Retinal fundus photograph, image size 2346x1568: 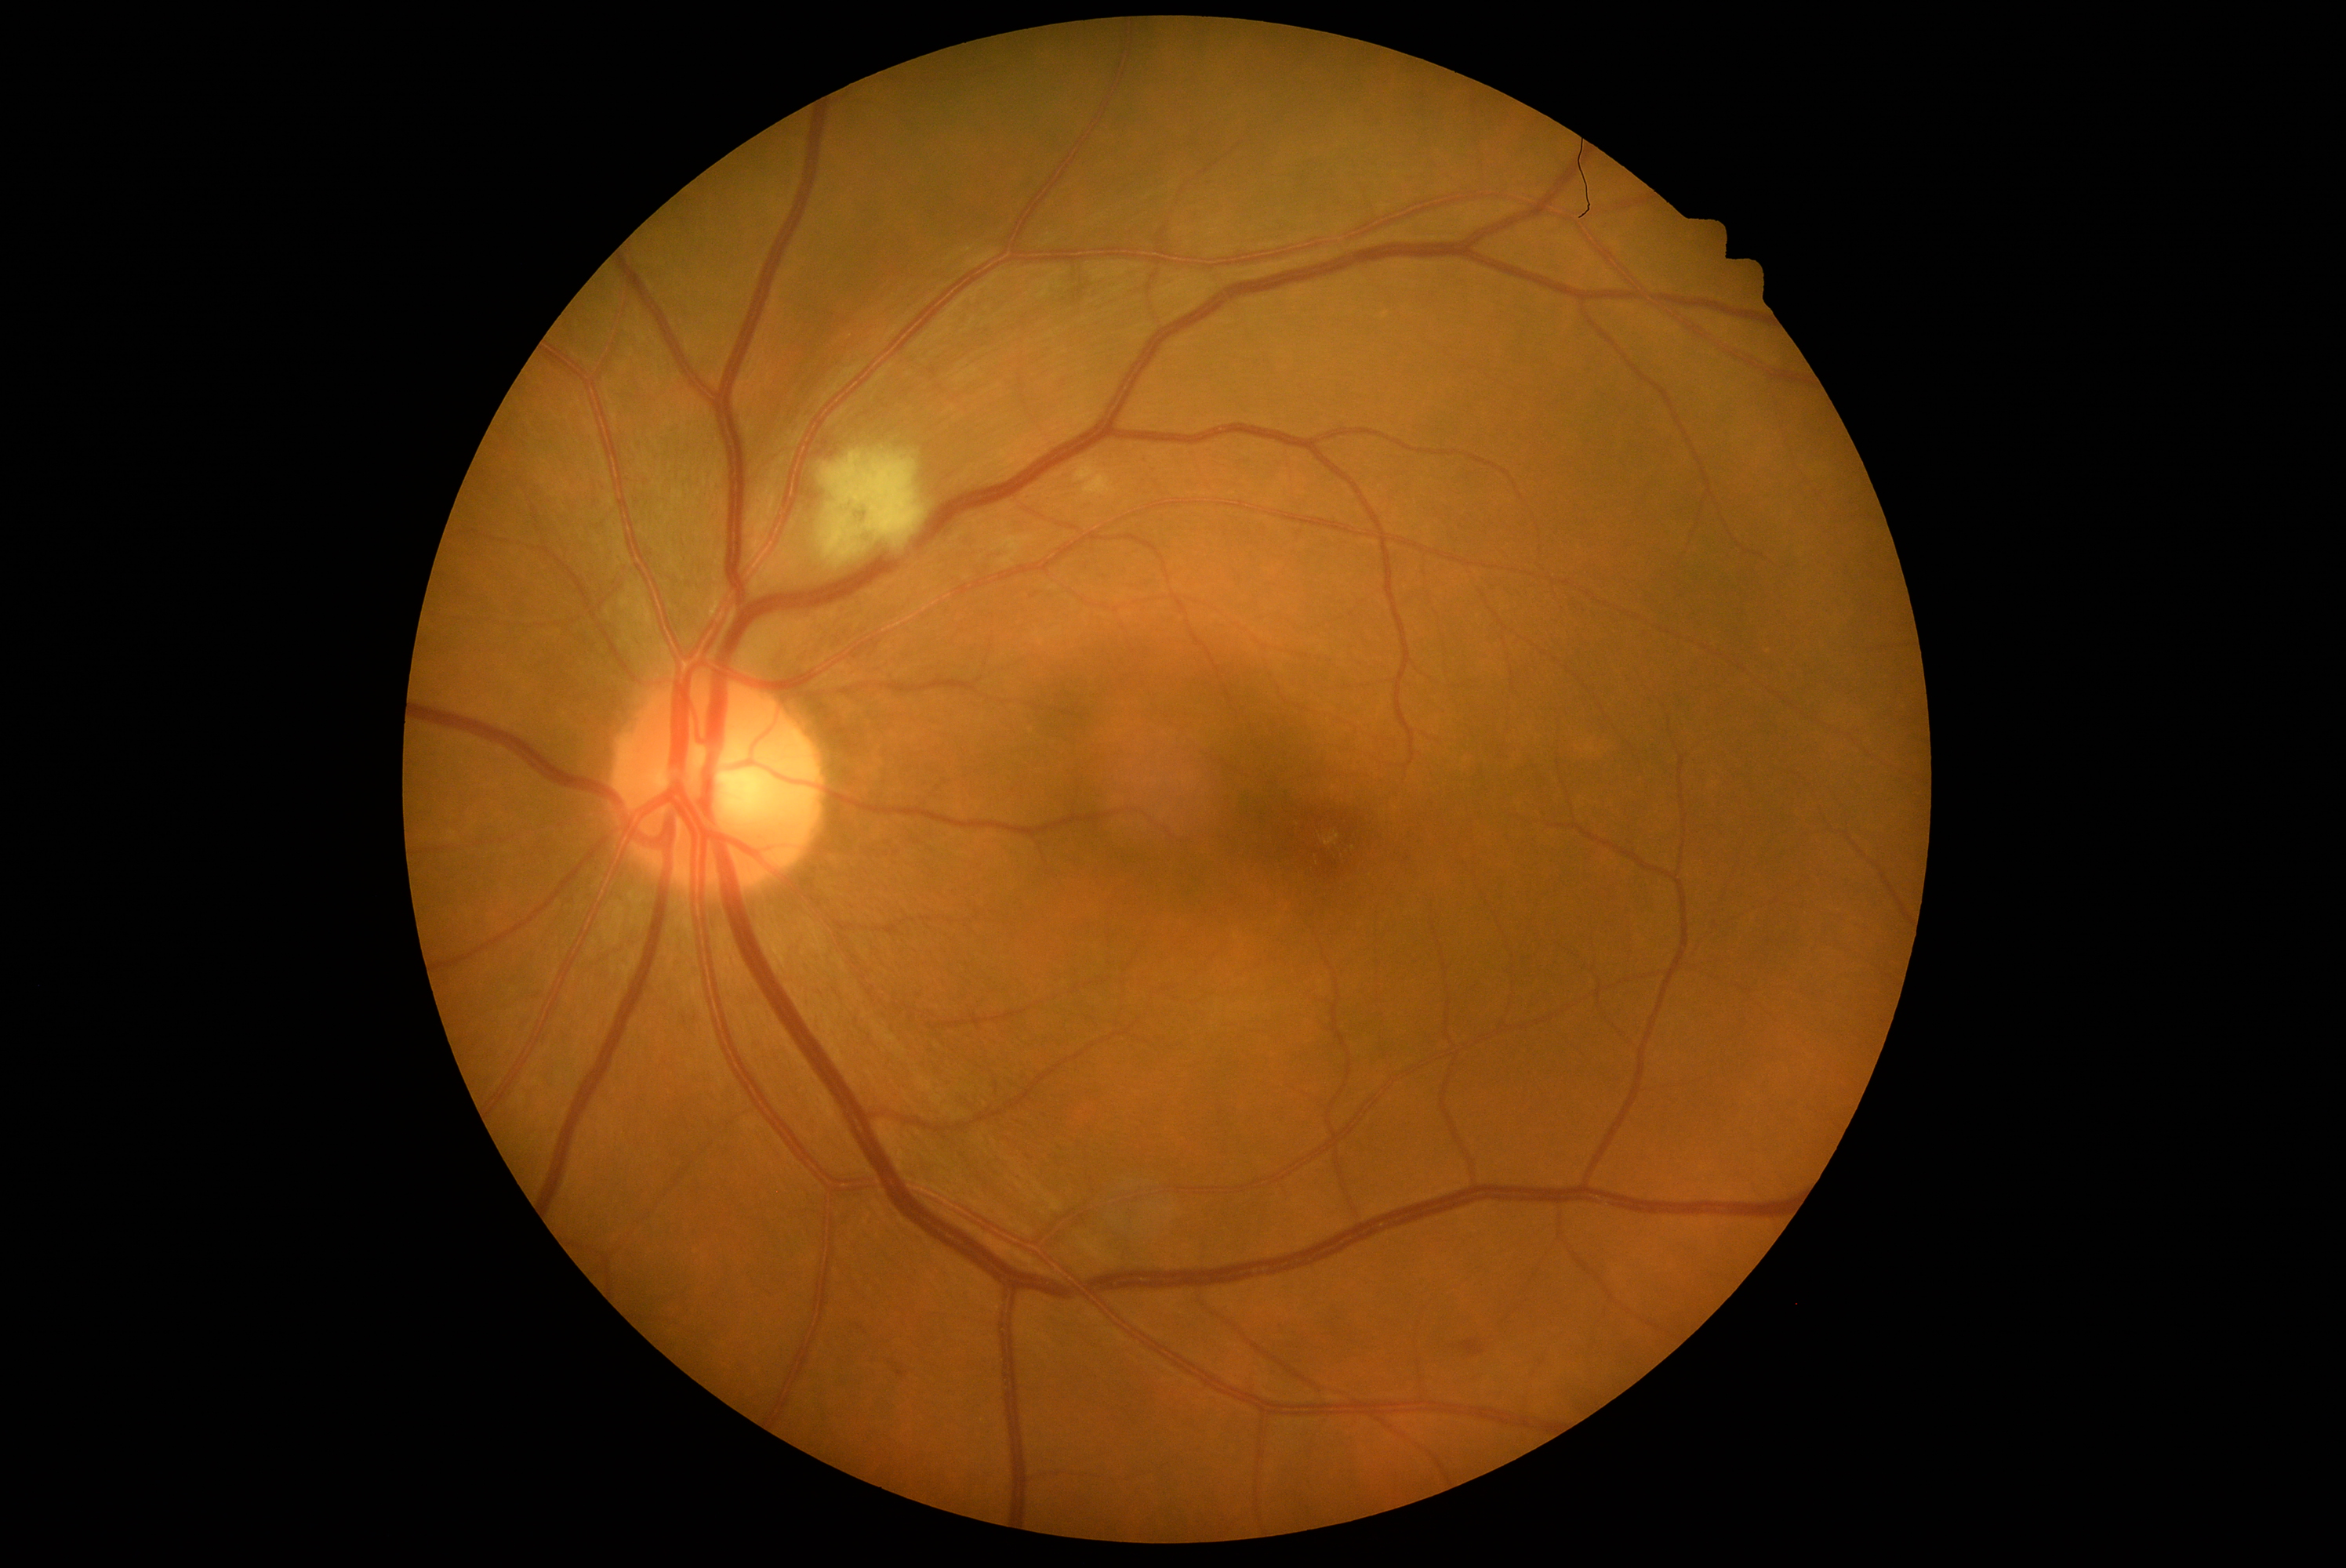

Diabetic retinopathy (DR): moderate NPDR (grade 2).